Centered on the optic disc · non-mydriatic acquisition · acquired with a Nidek AFC-330: 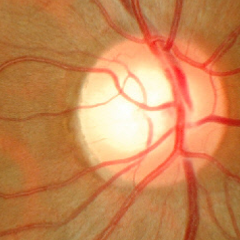

Glaucoma assessment: no glaucomatous optic neuropathy.